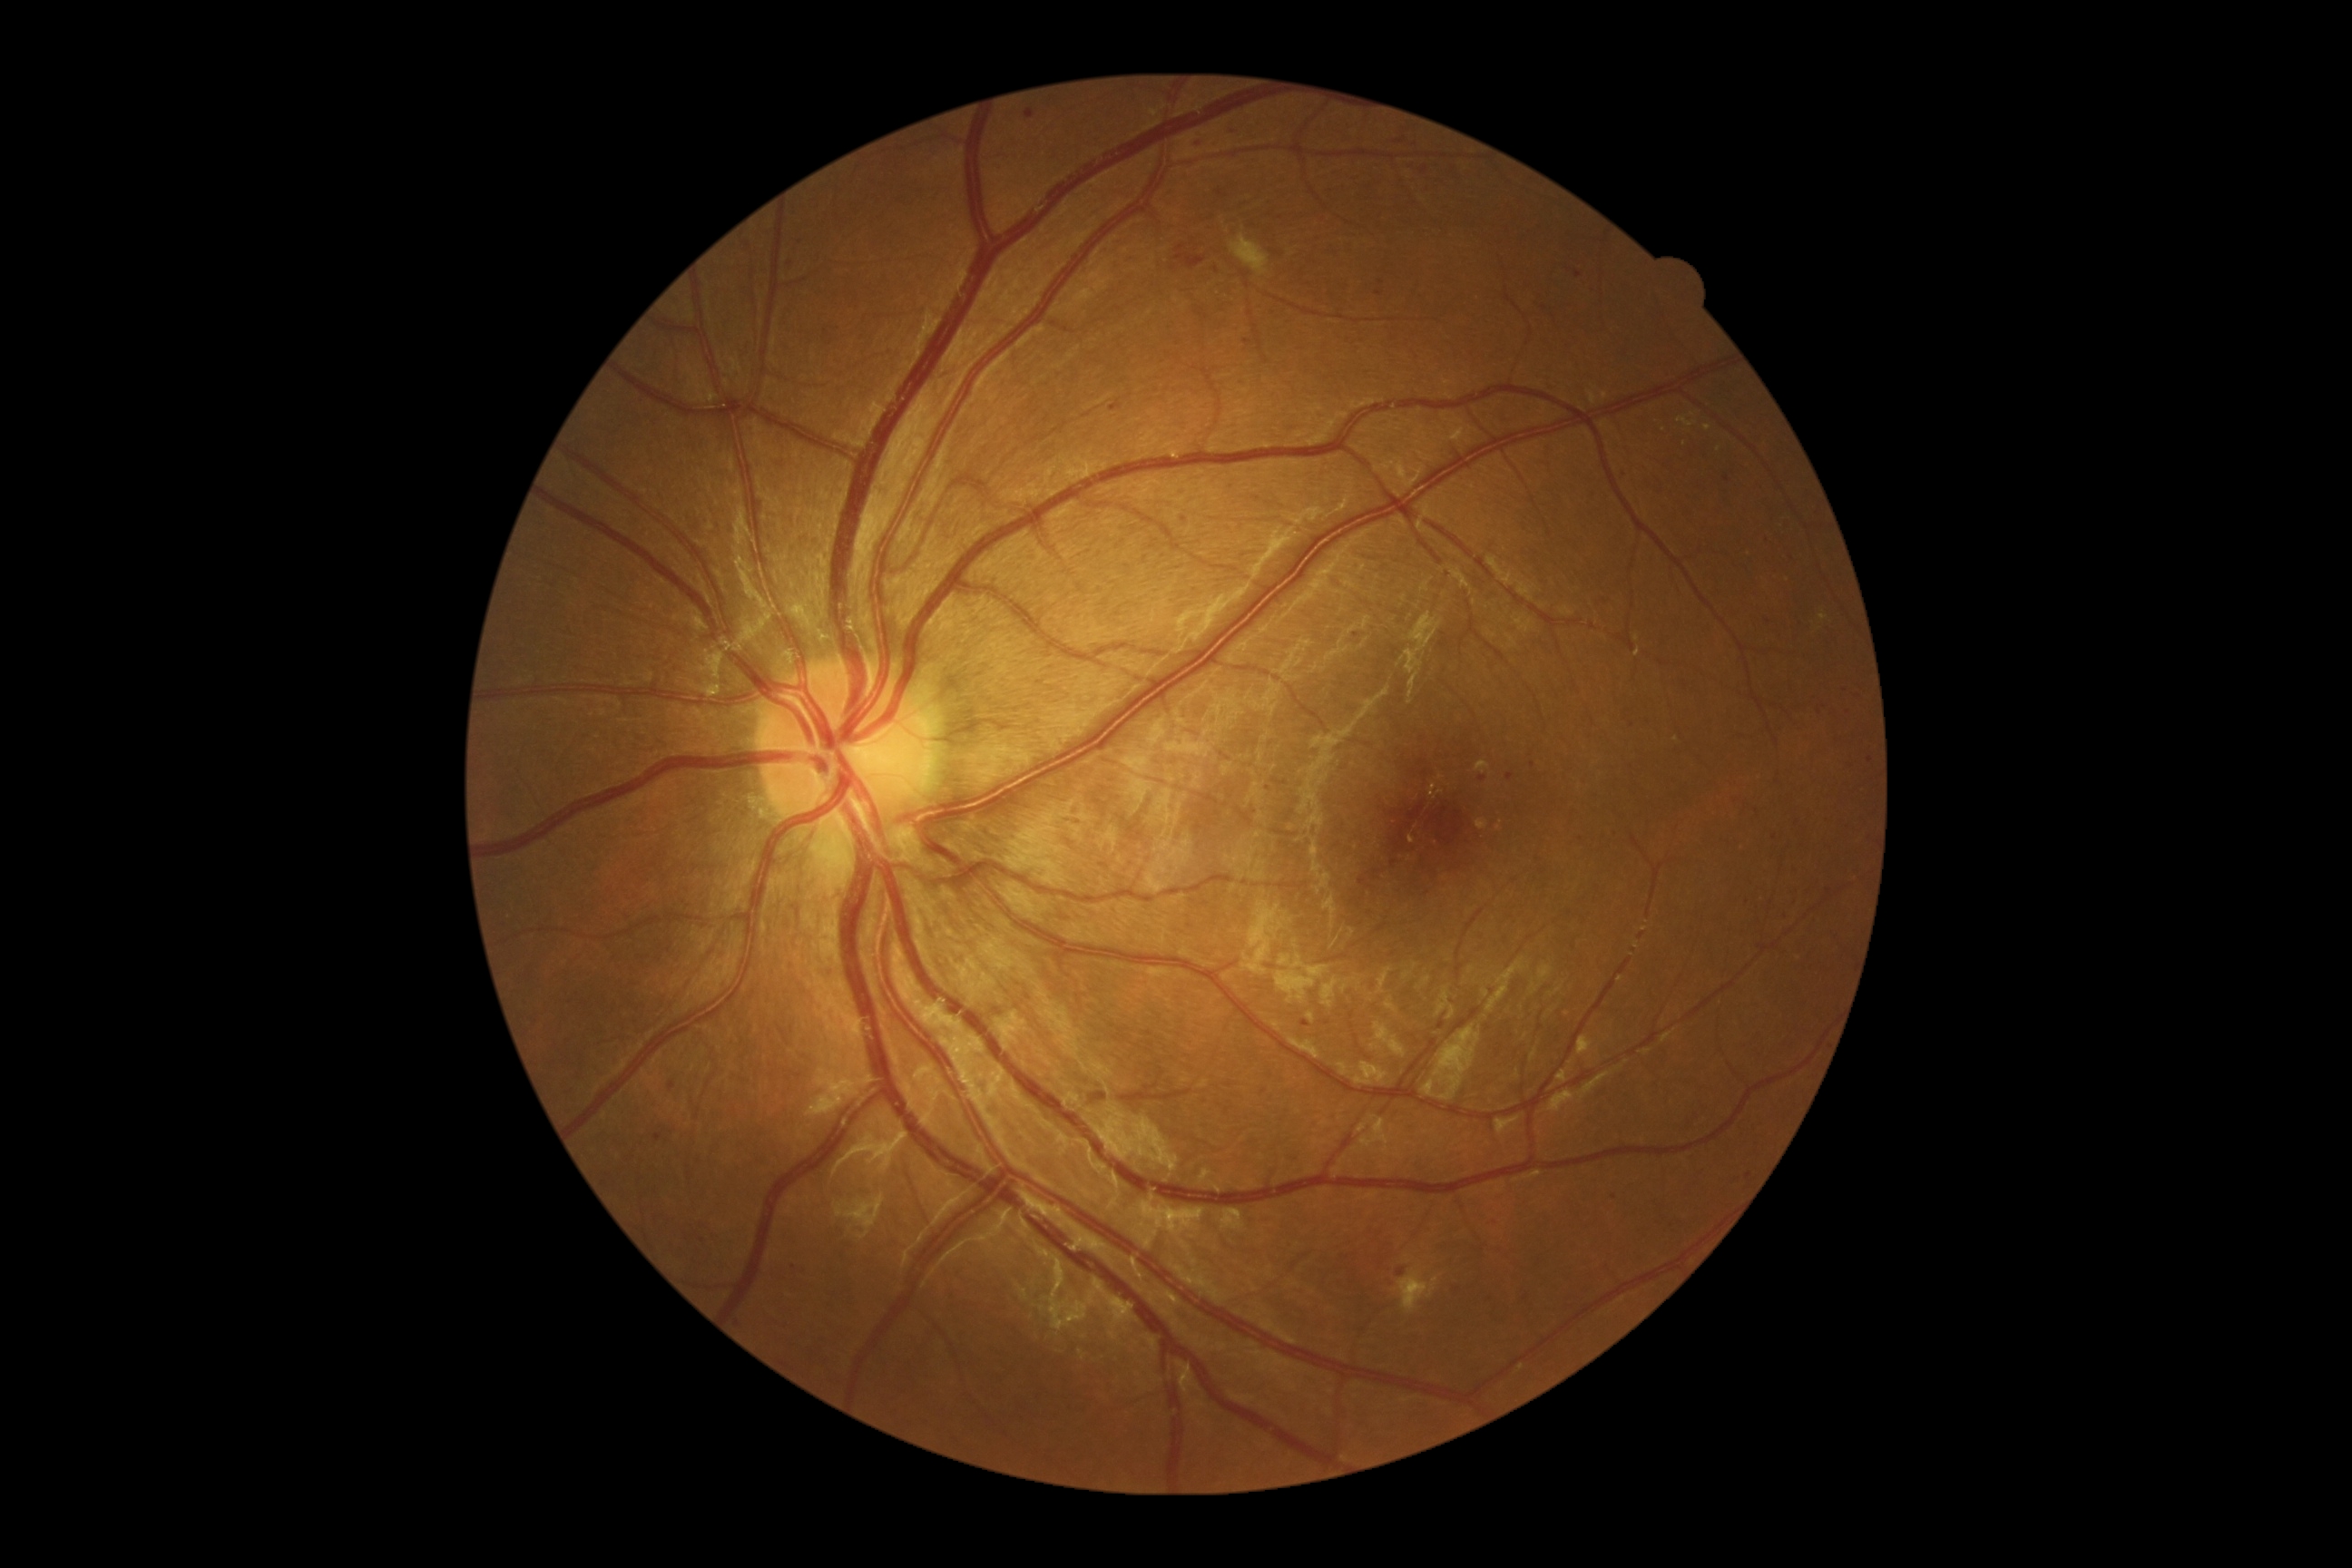
Diabetic retinopathy (DR): 2/4.